CFP, 848x848px — 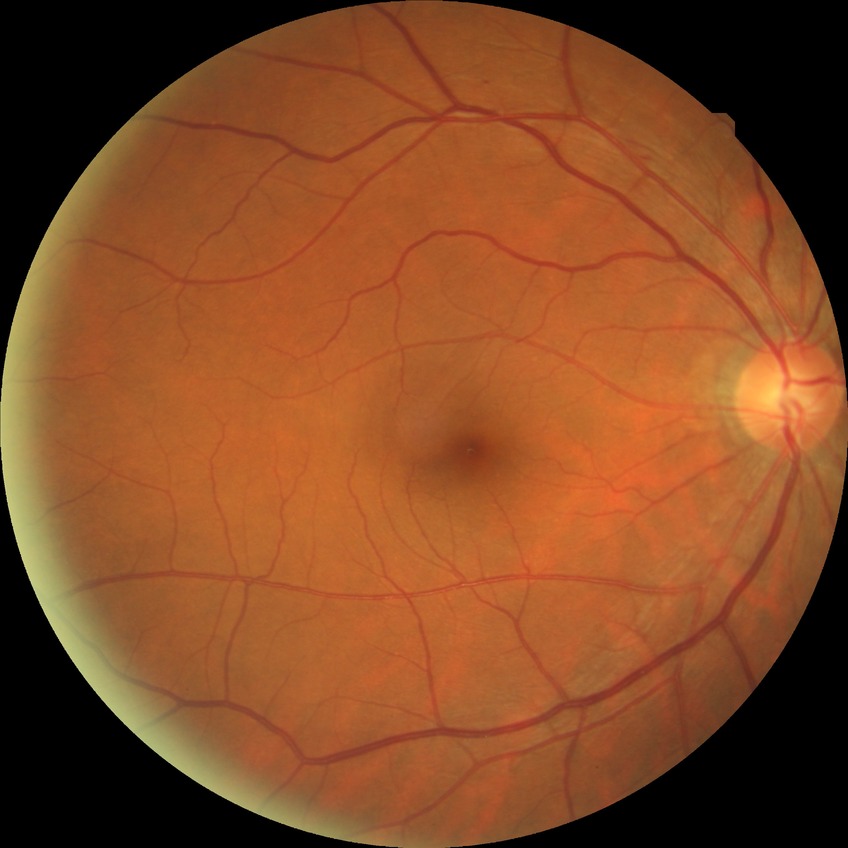
retinopathy stage: no diabetic retinopathy